Retinal fundus photograph · 2352x1568px · FOV: 45 degrees — 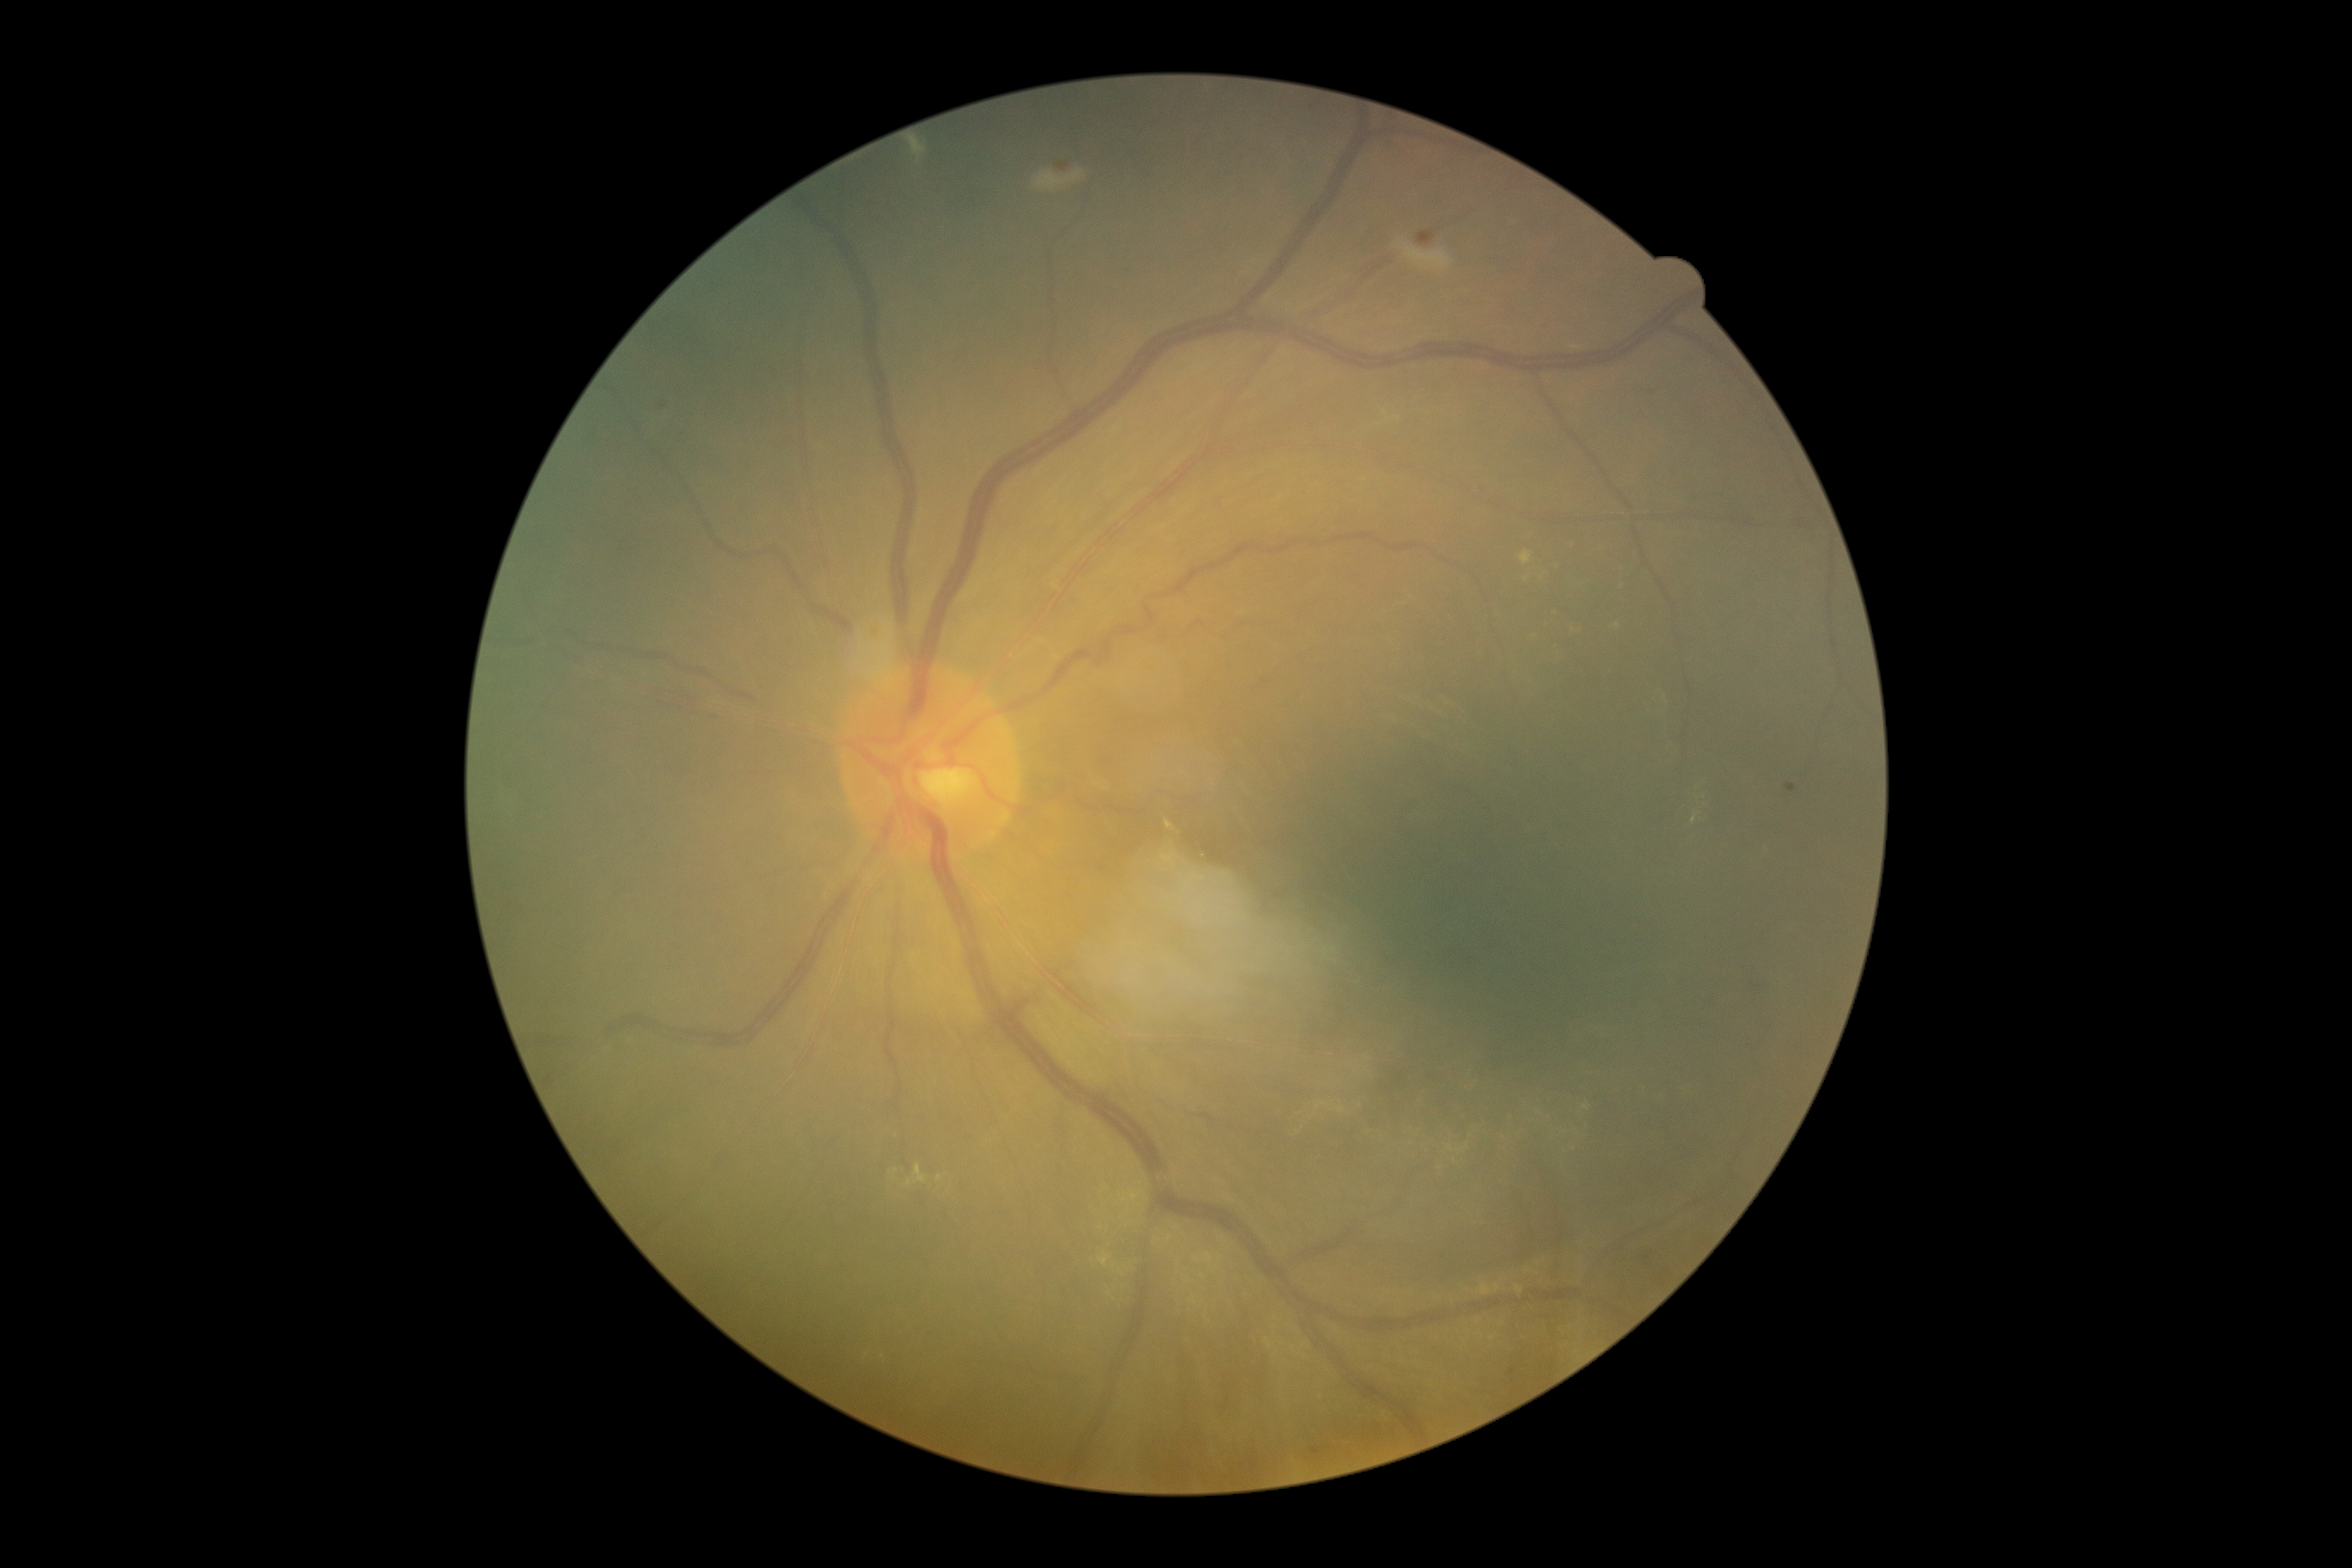
Diabetic retinopathy grade: 2 — more than just microaneurysms but less than severe NPDR.